Graded on the modified Davis scale, fundus photo, acquired with a NIDEK AFC-230: 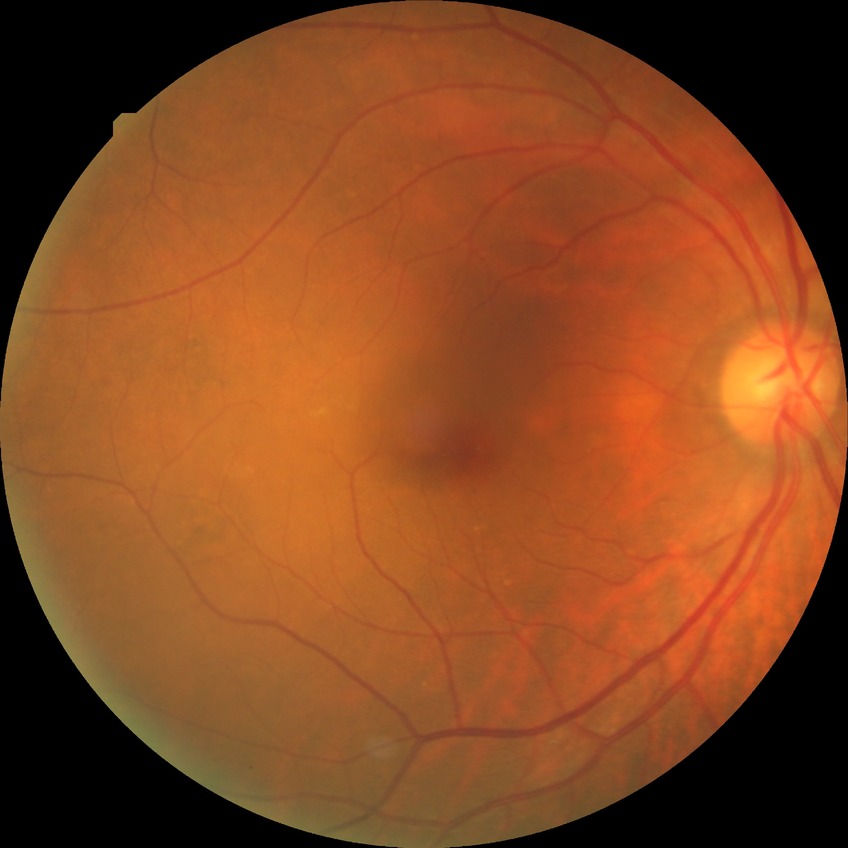 Diabetic retinopathy (DR): no diabetic retinopathy (NDR).